2212x1659px; 45-degree field of view — 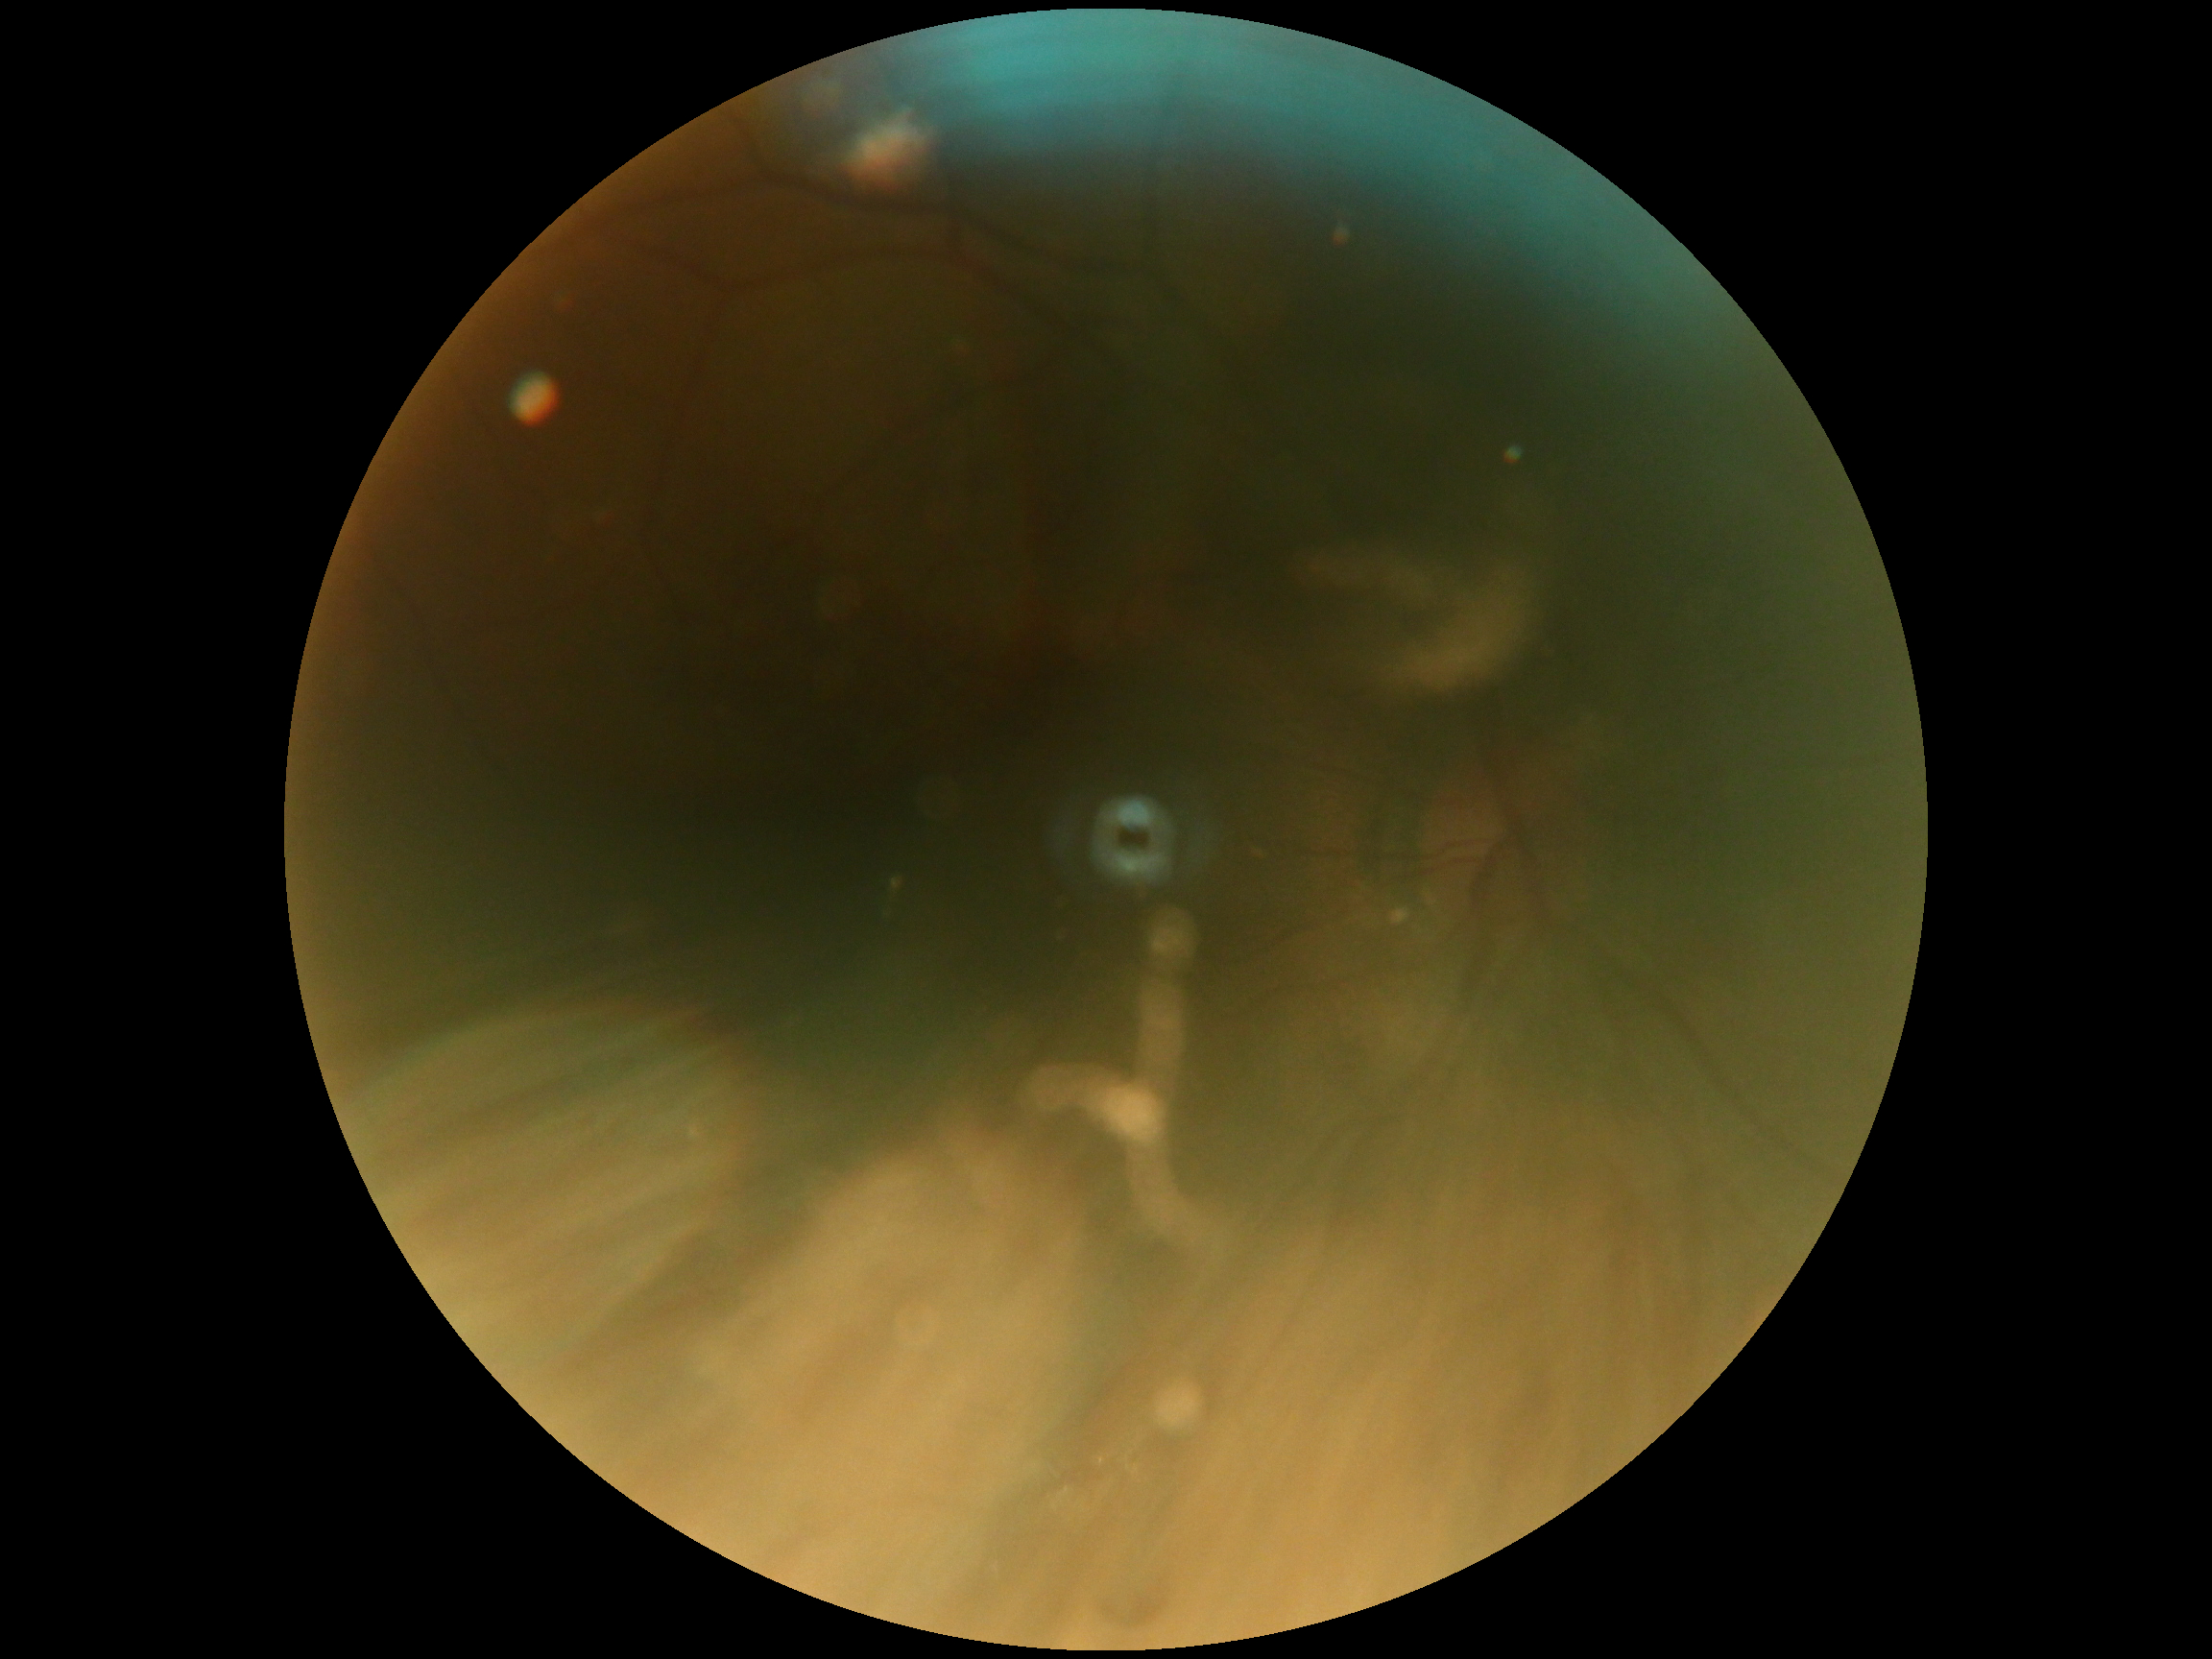 DR stage is ungradable.